Acquired with a Nidek AFC-330 — 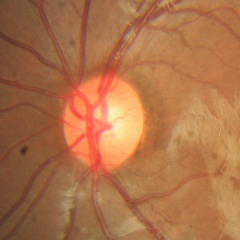
Optic nerve head appearance consistent with no glaucomatous findings.